2352x1568, retinal fundus photograph, 45° FOV — 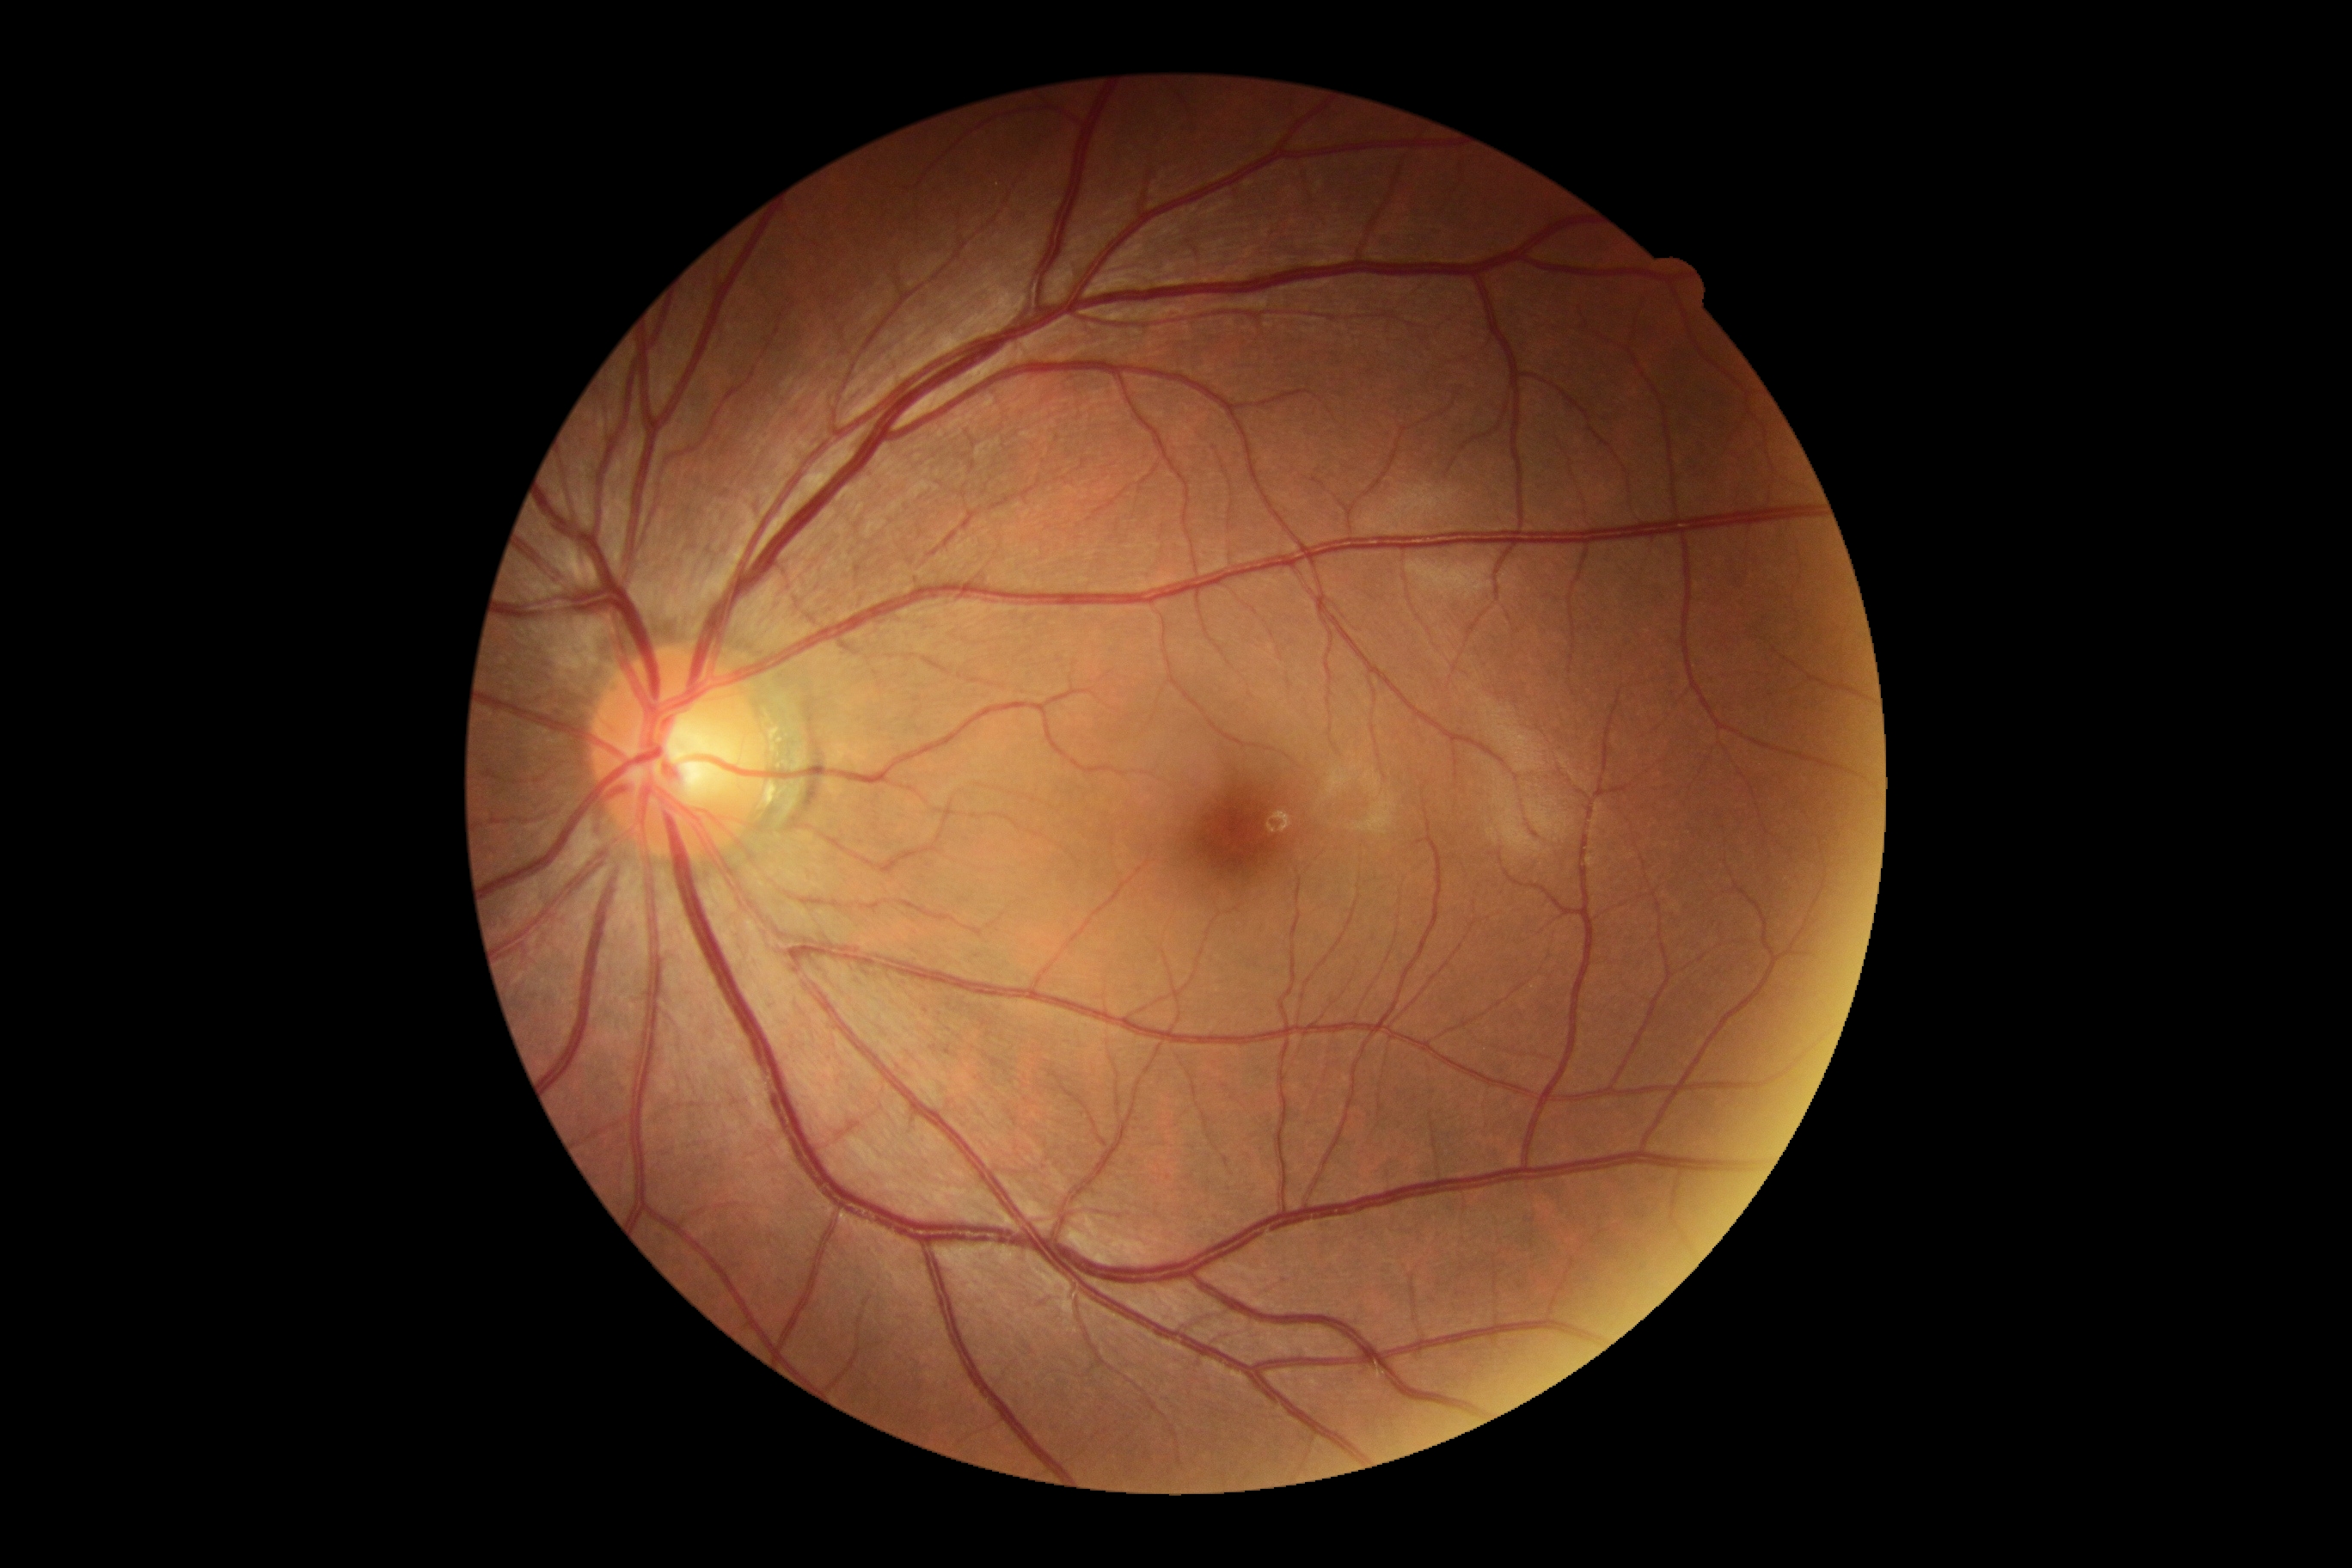
No apparent diabetic retinopathy.
Diabetic retinopathy is grade 0.